Acquired on the Phoenix ICON; image size 1240x1240; infant wide-field retinal image
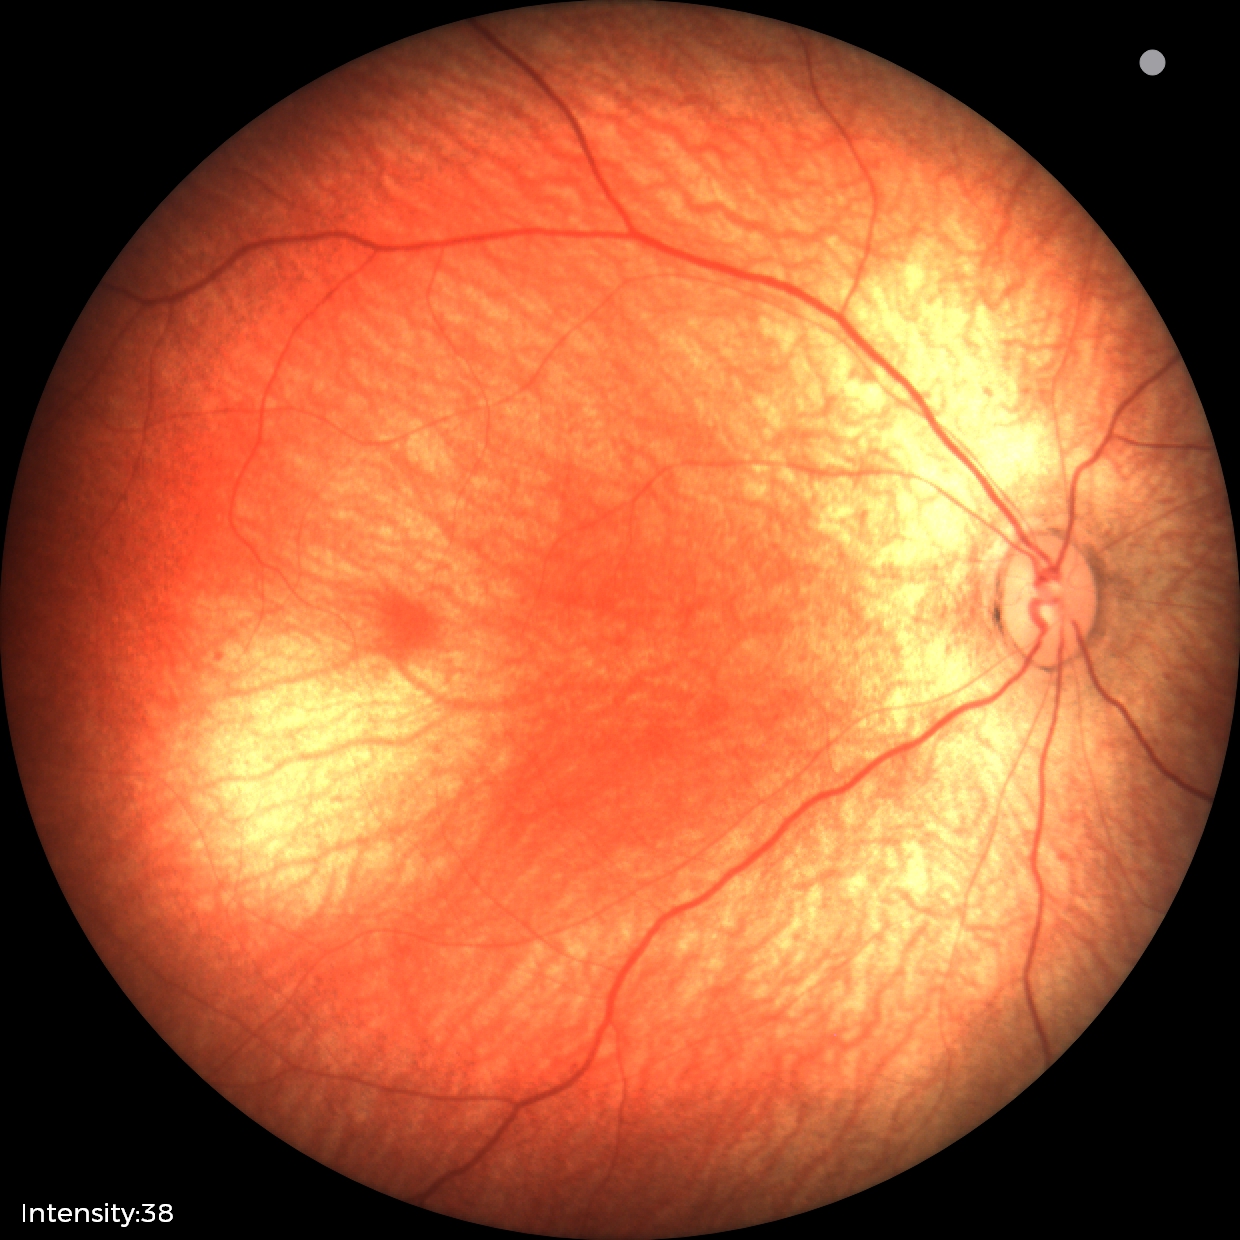
Examination with physiological retinal findings.